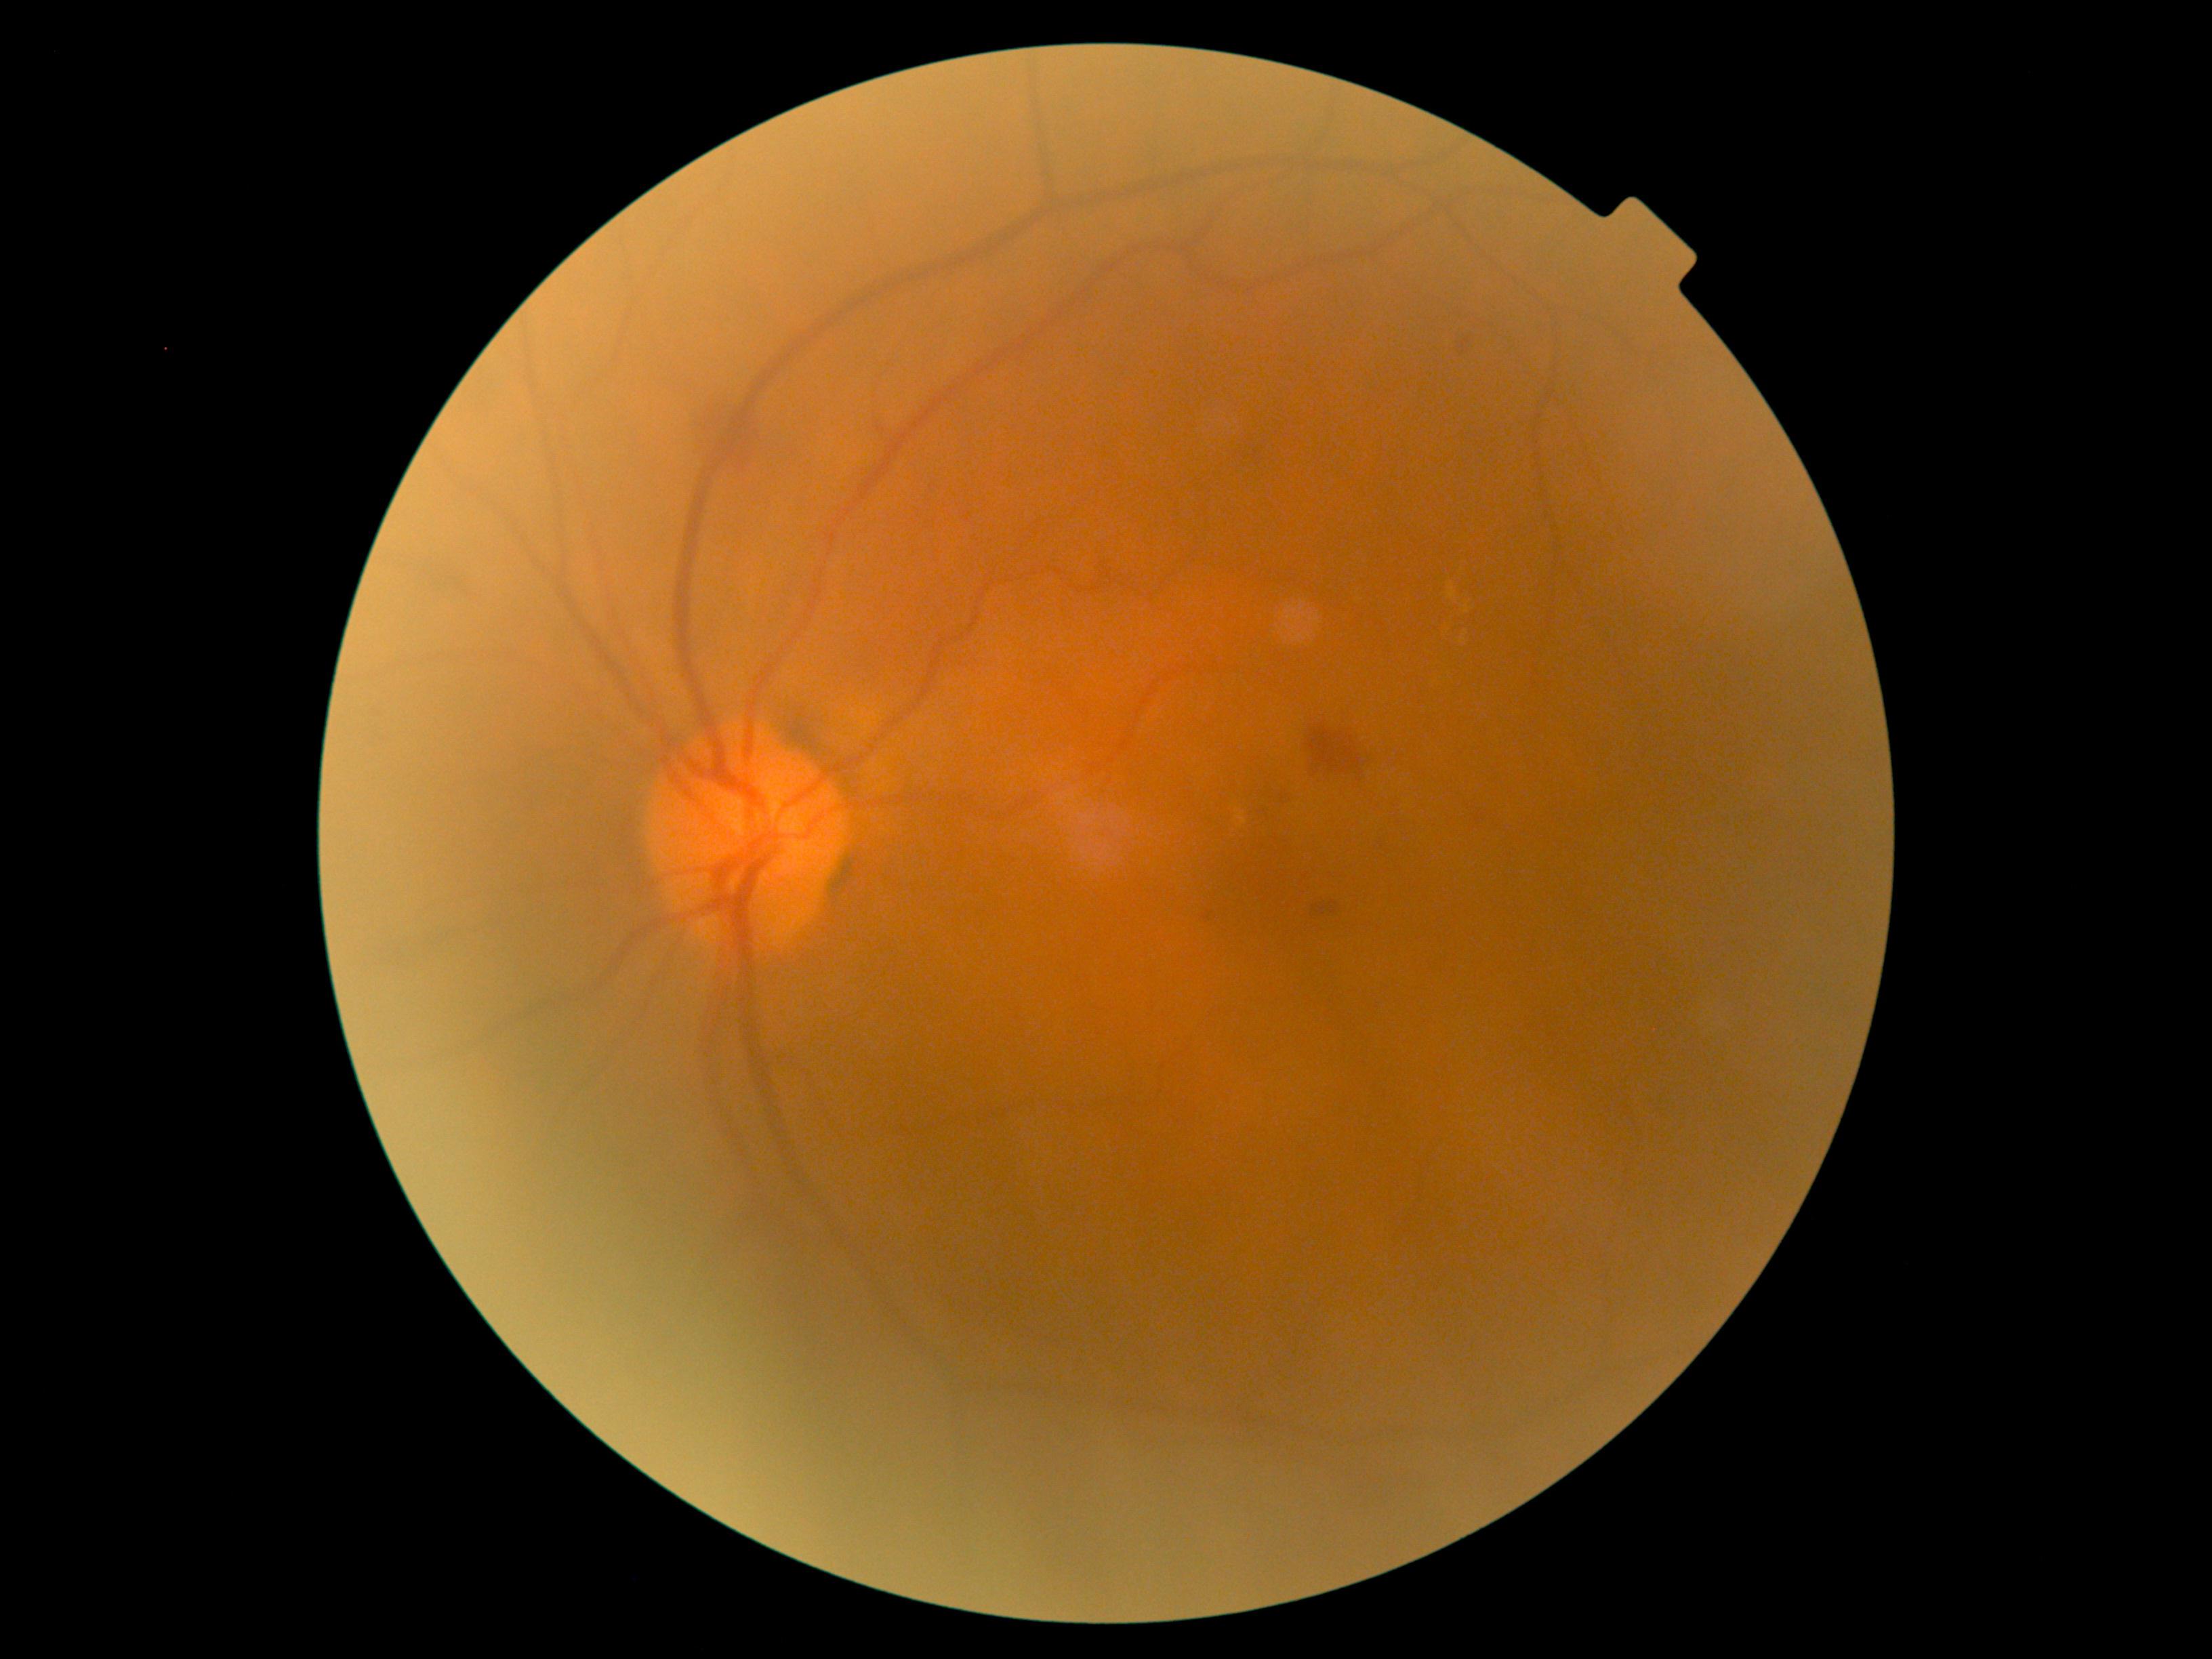 DR severity: grade 2.
DR class: non-proliferative diabetic retinopathy.